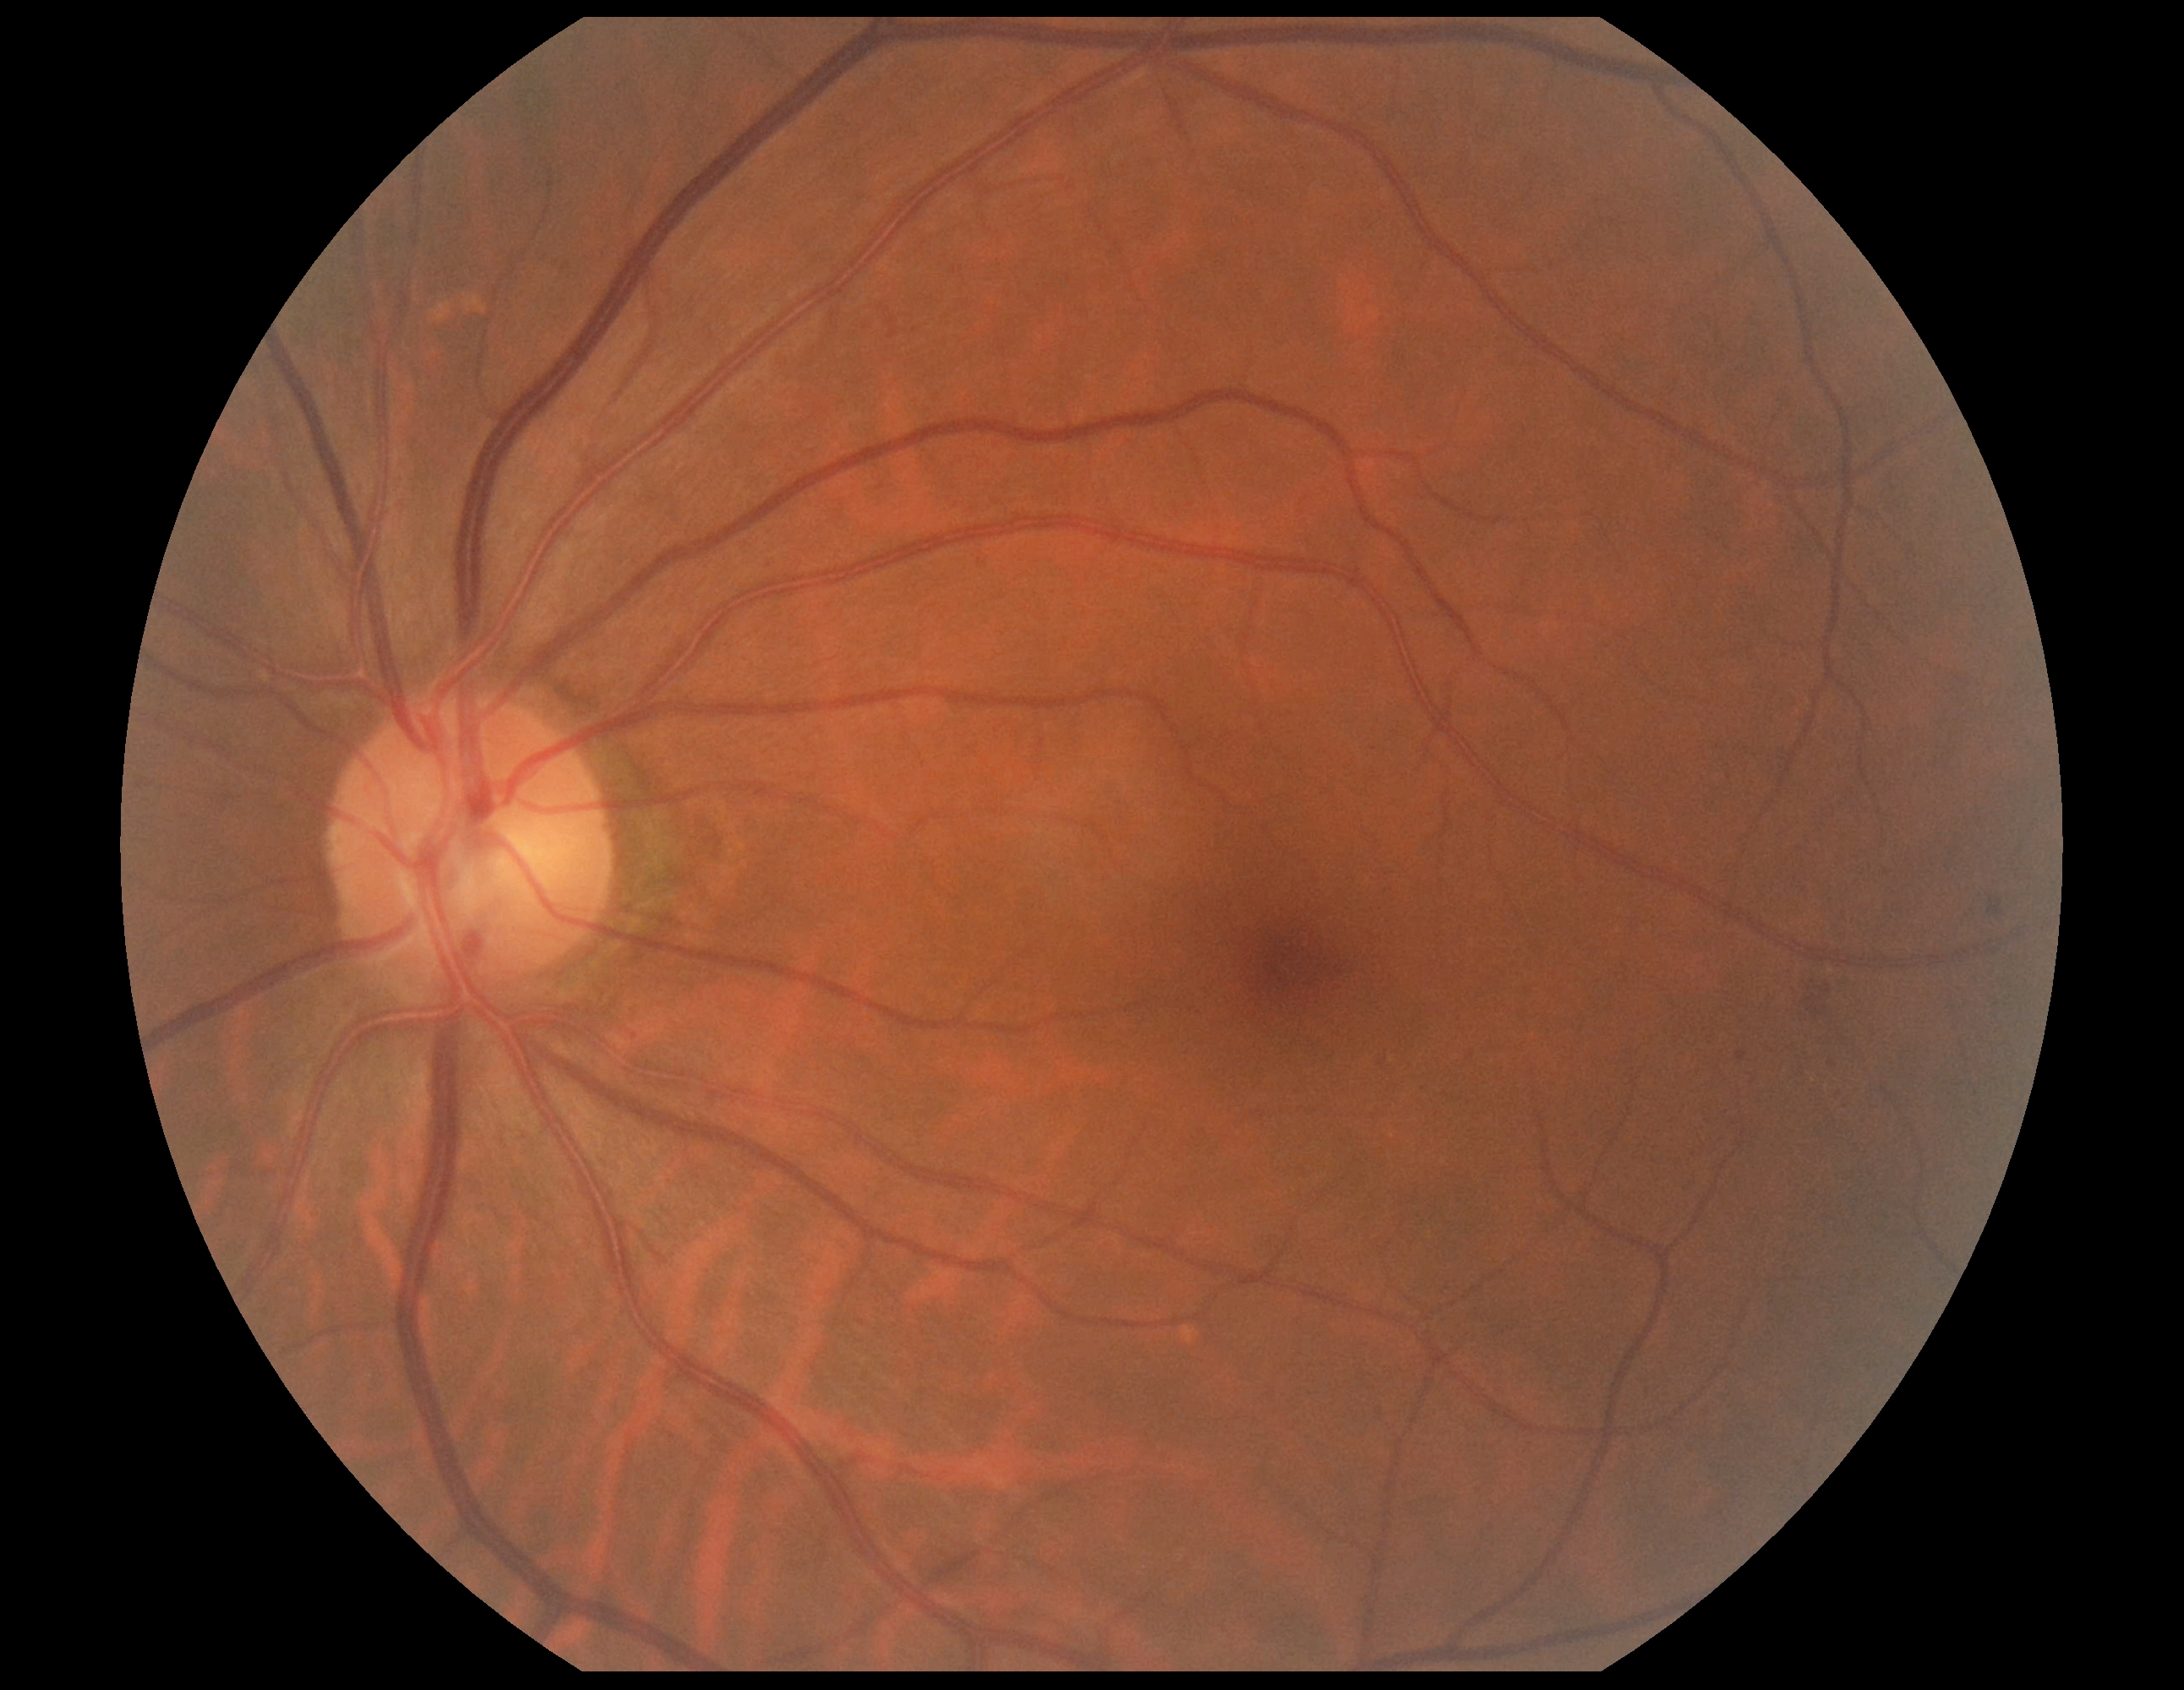

Diabetic retinopathy grade: 2/4.